848 by 848 pixels; 45-degree field of view; color fundus image; nonmydriatic fundus photograph
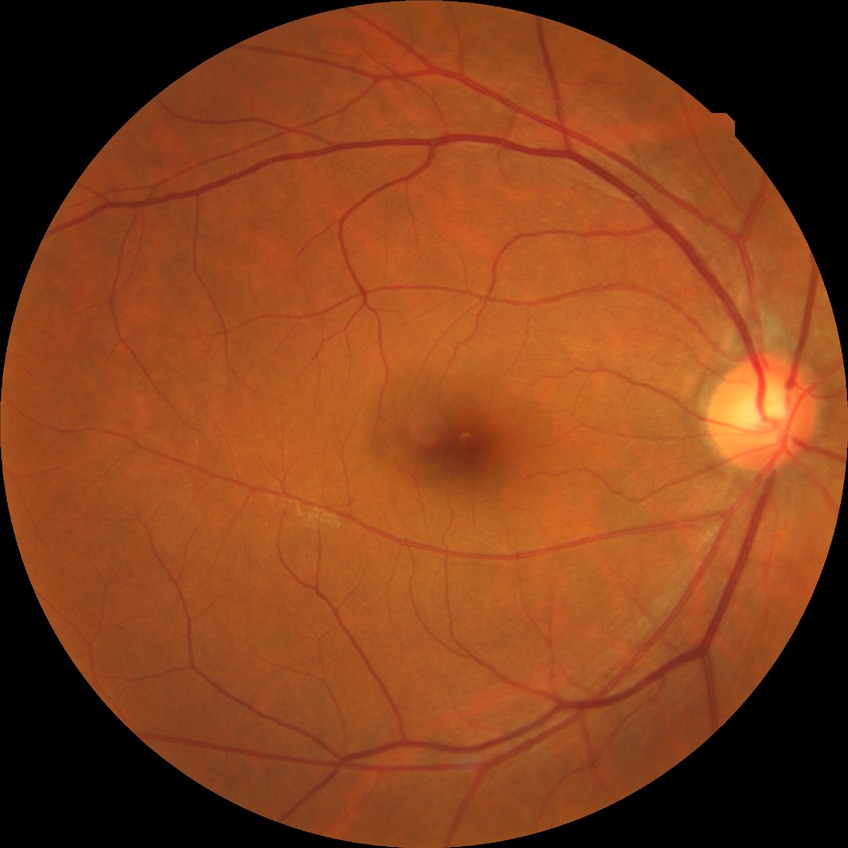

DR severity: NDR.